Color fundus photograph. Acquired with a Canon CR-1.
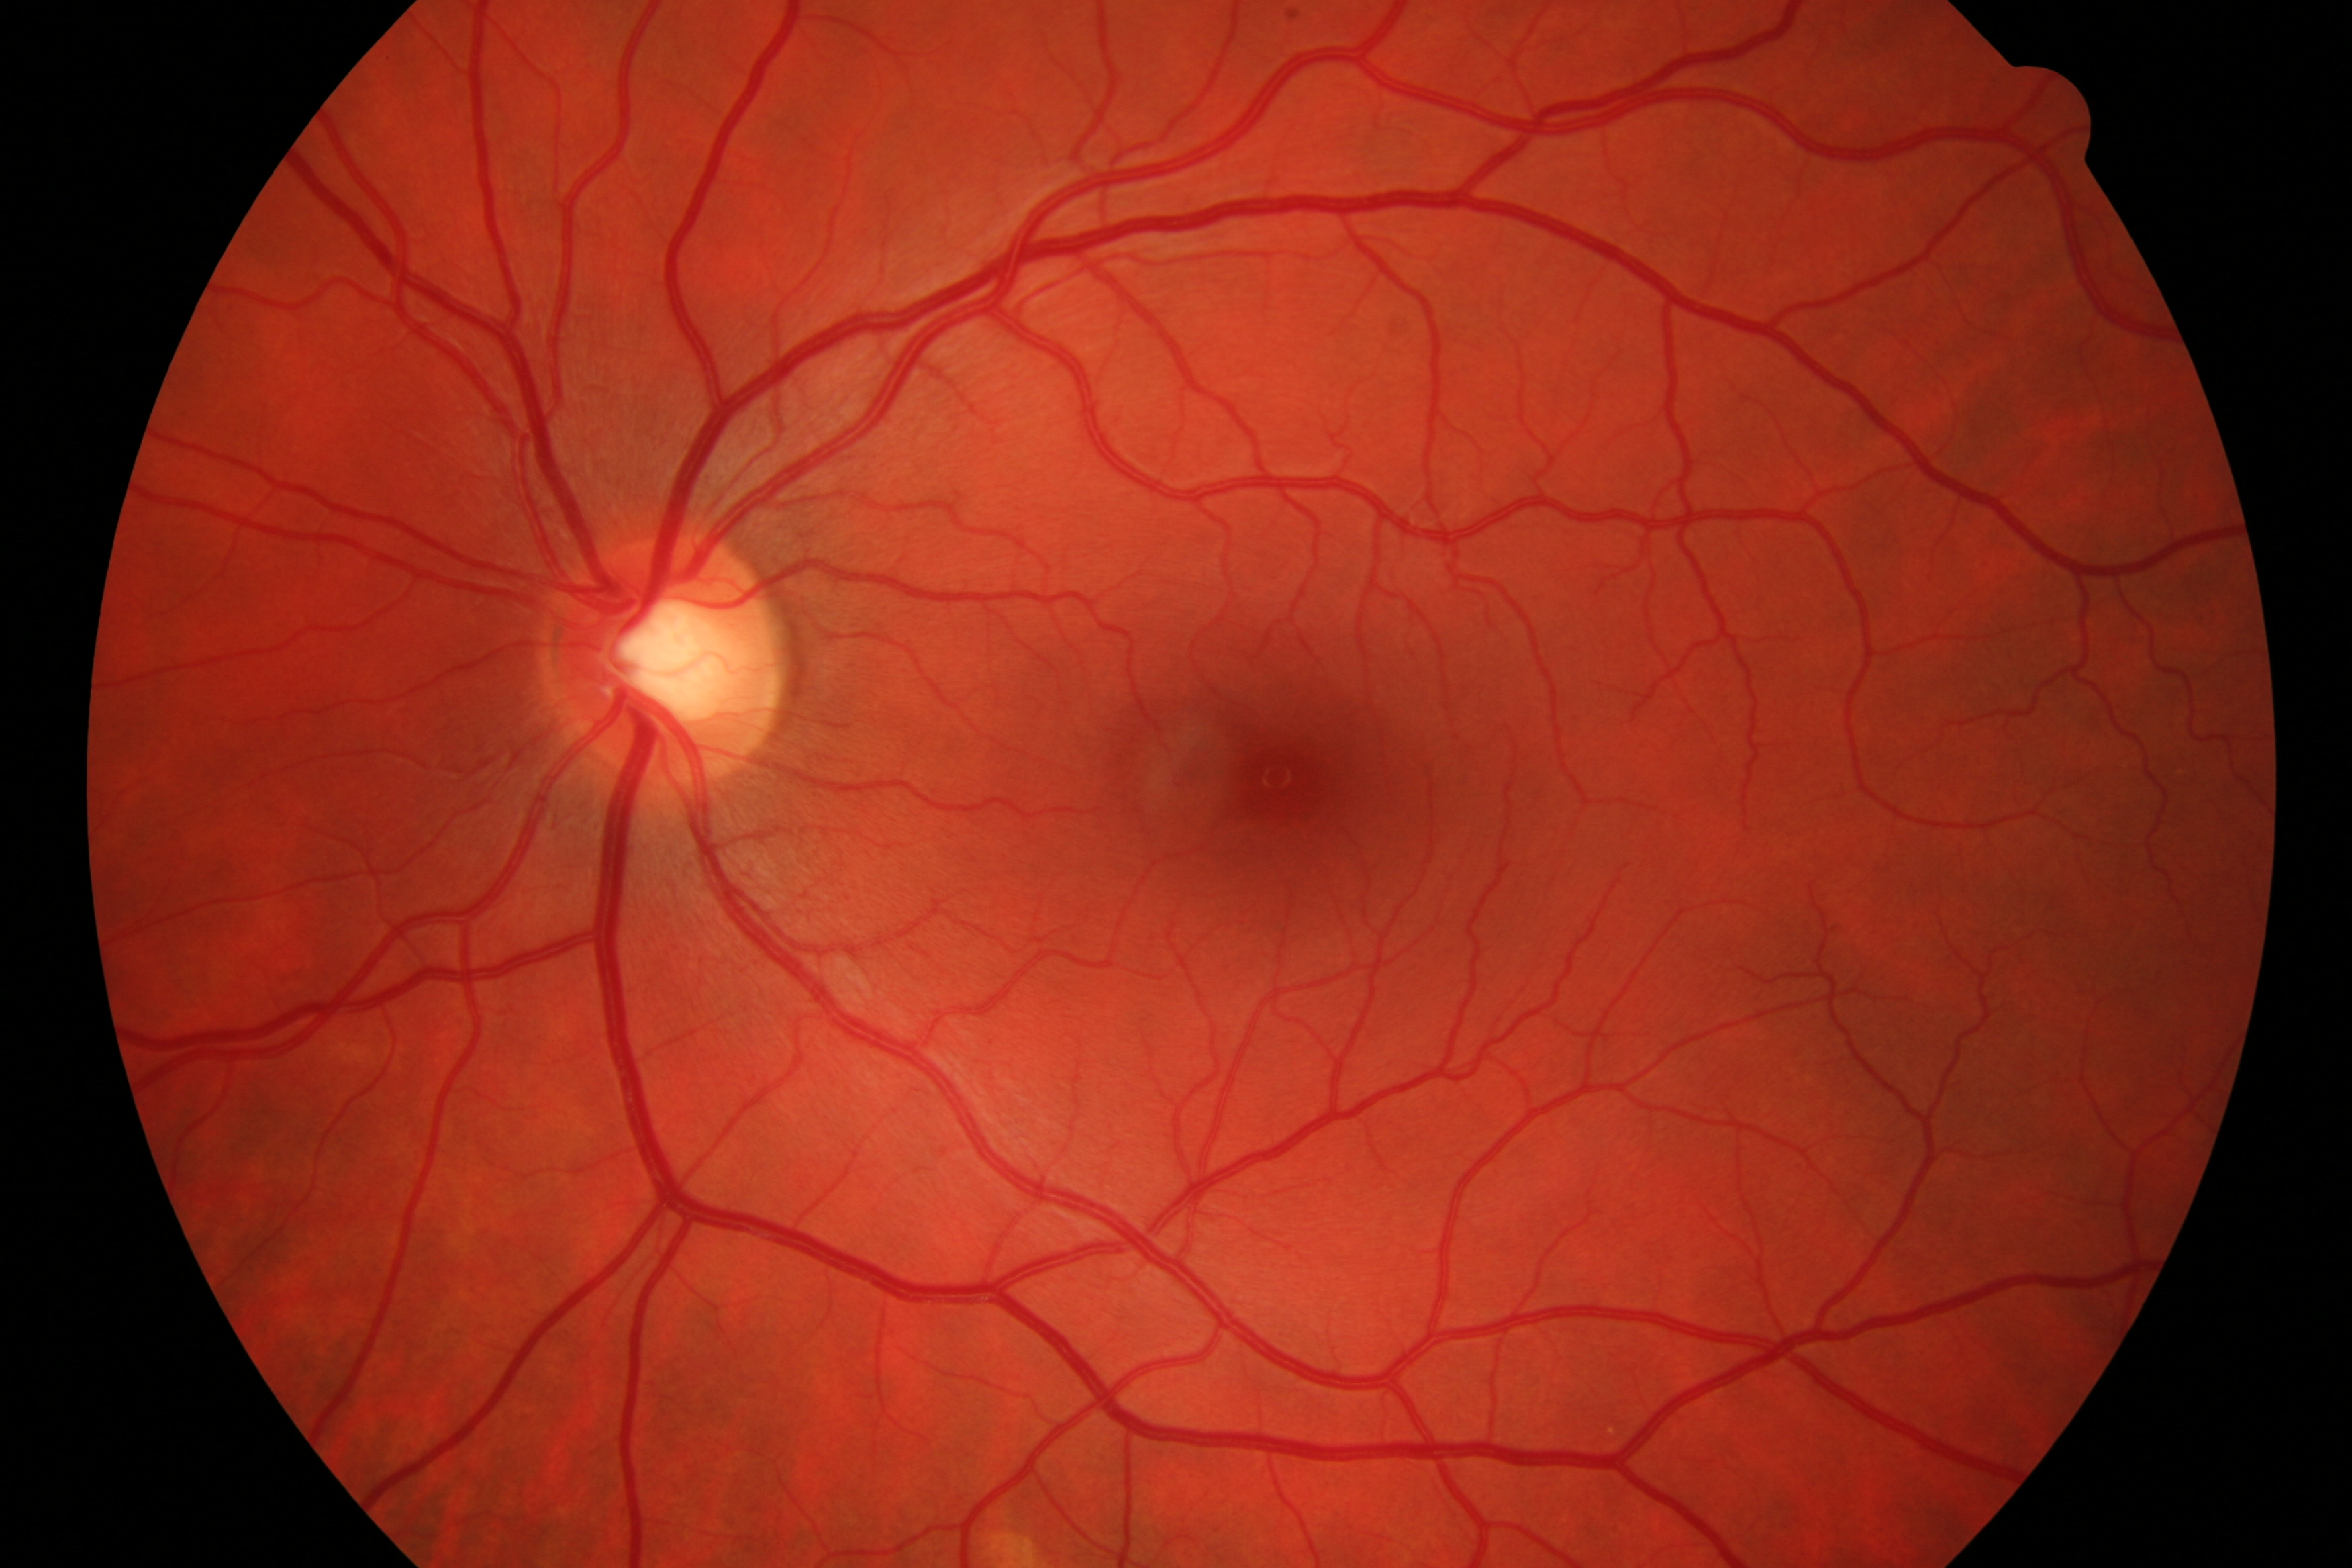 Diagnosis: negative for diabetic retinopathy and glaucoma.